848 x 848 pixels; color fundus image; camera: NIDEK AFC-230; no pharmacologic dilation:
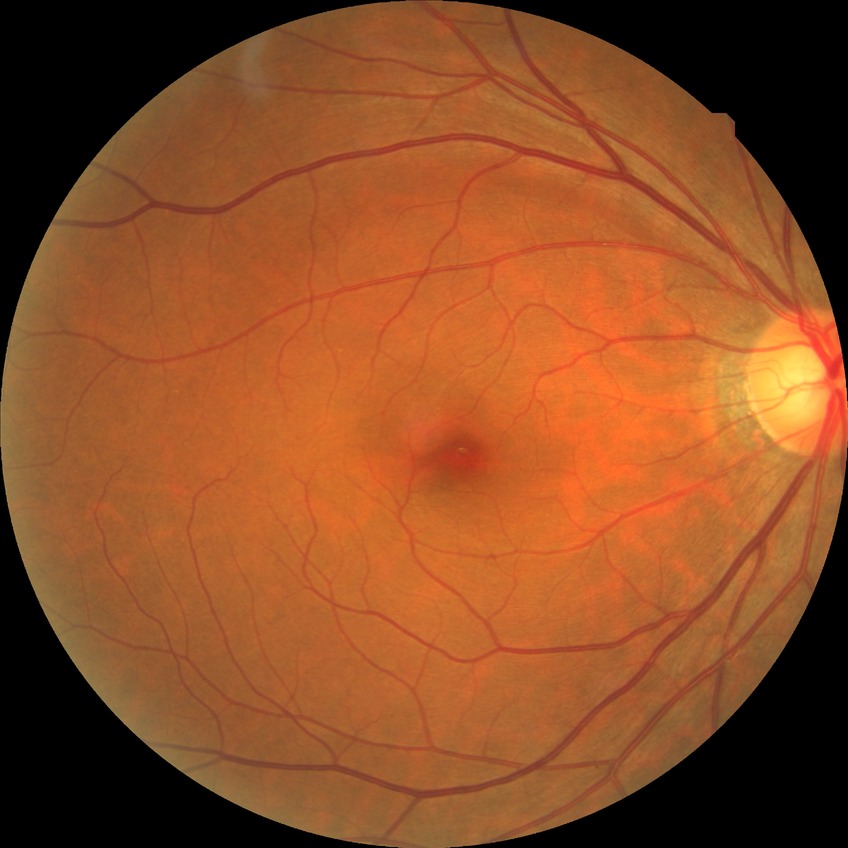

Diabetic retinopathy (DR): no diabetic retinopathy (NDR).